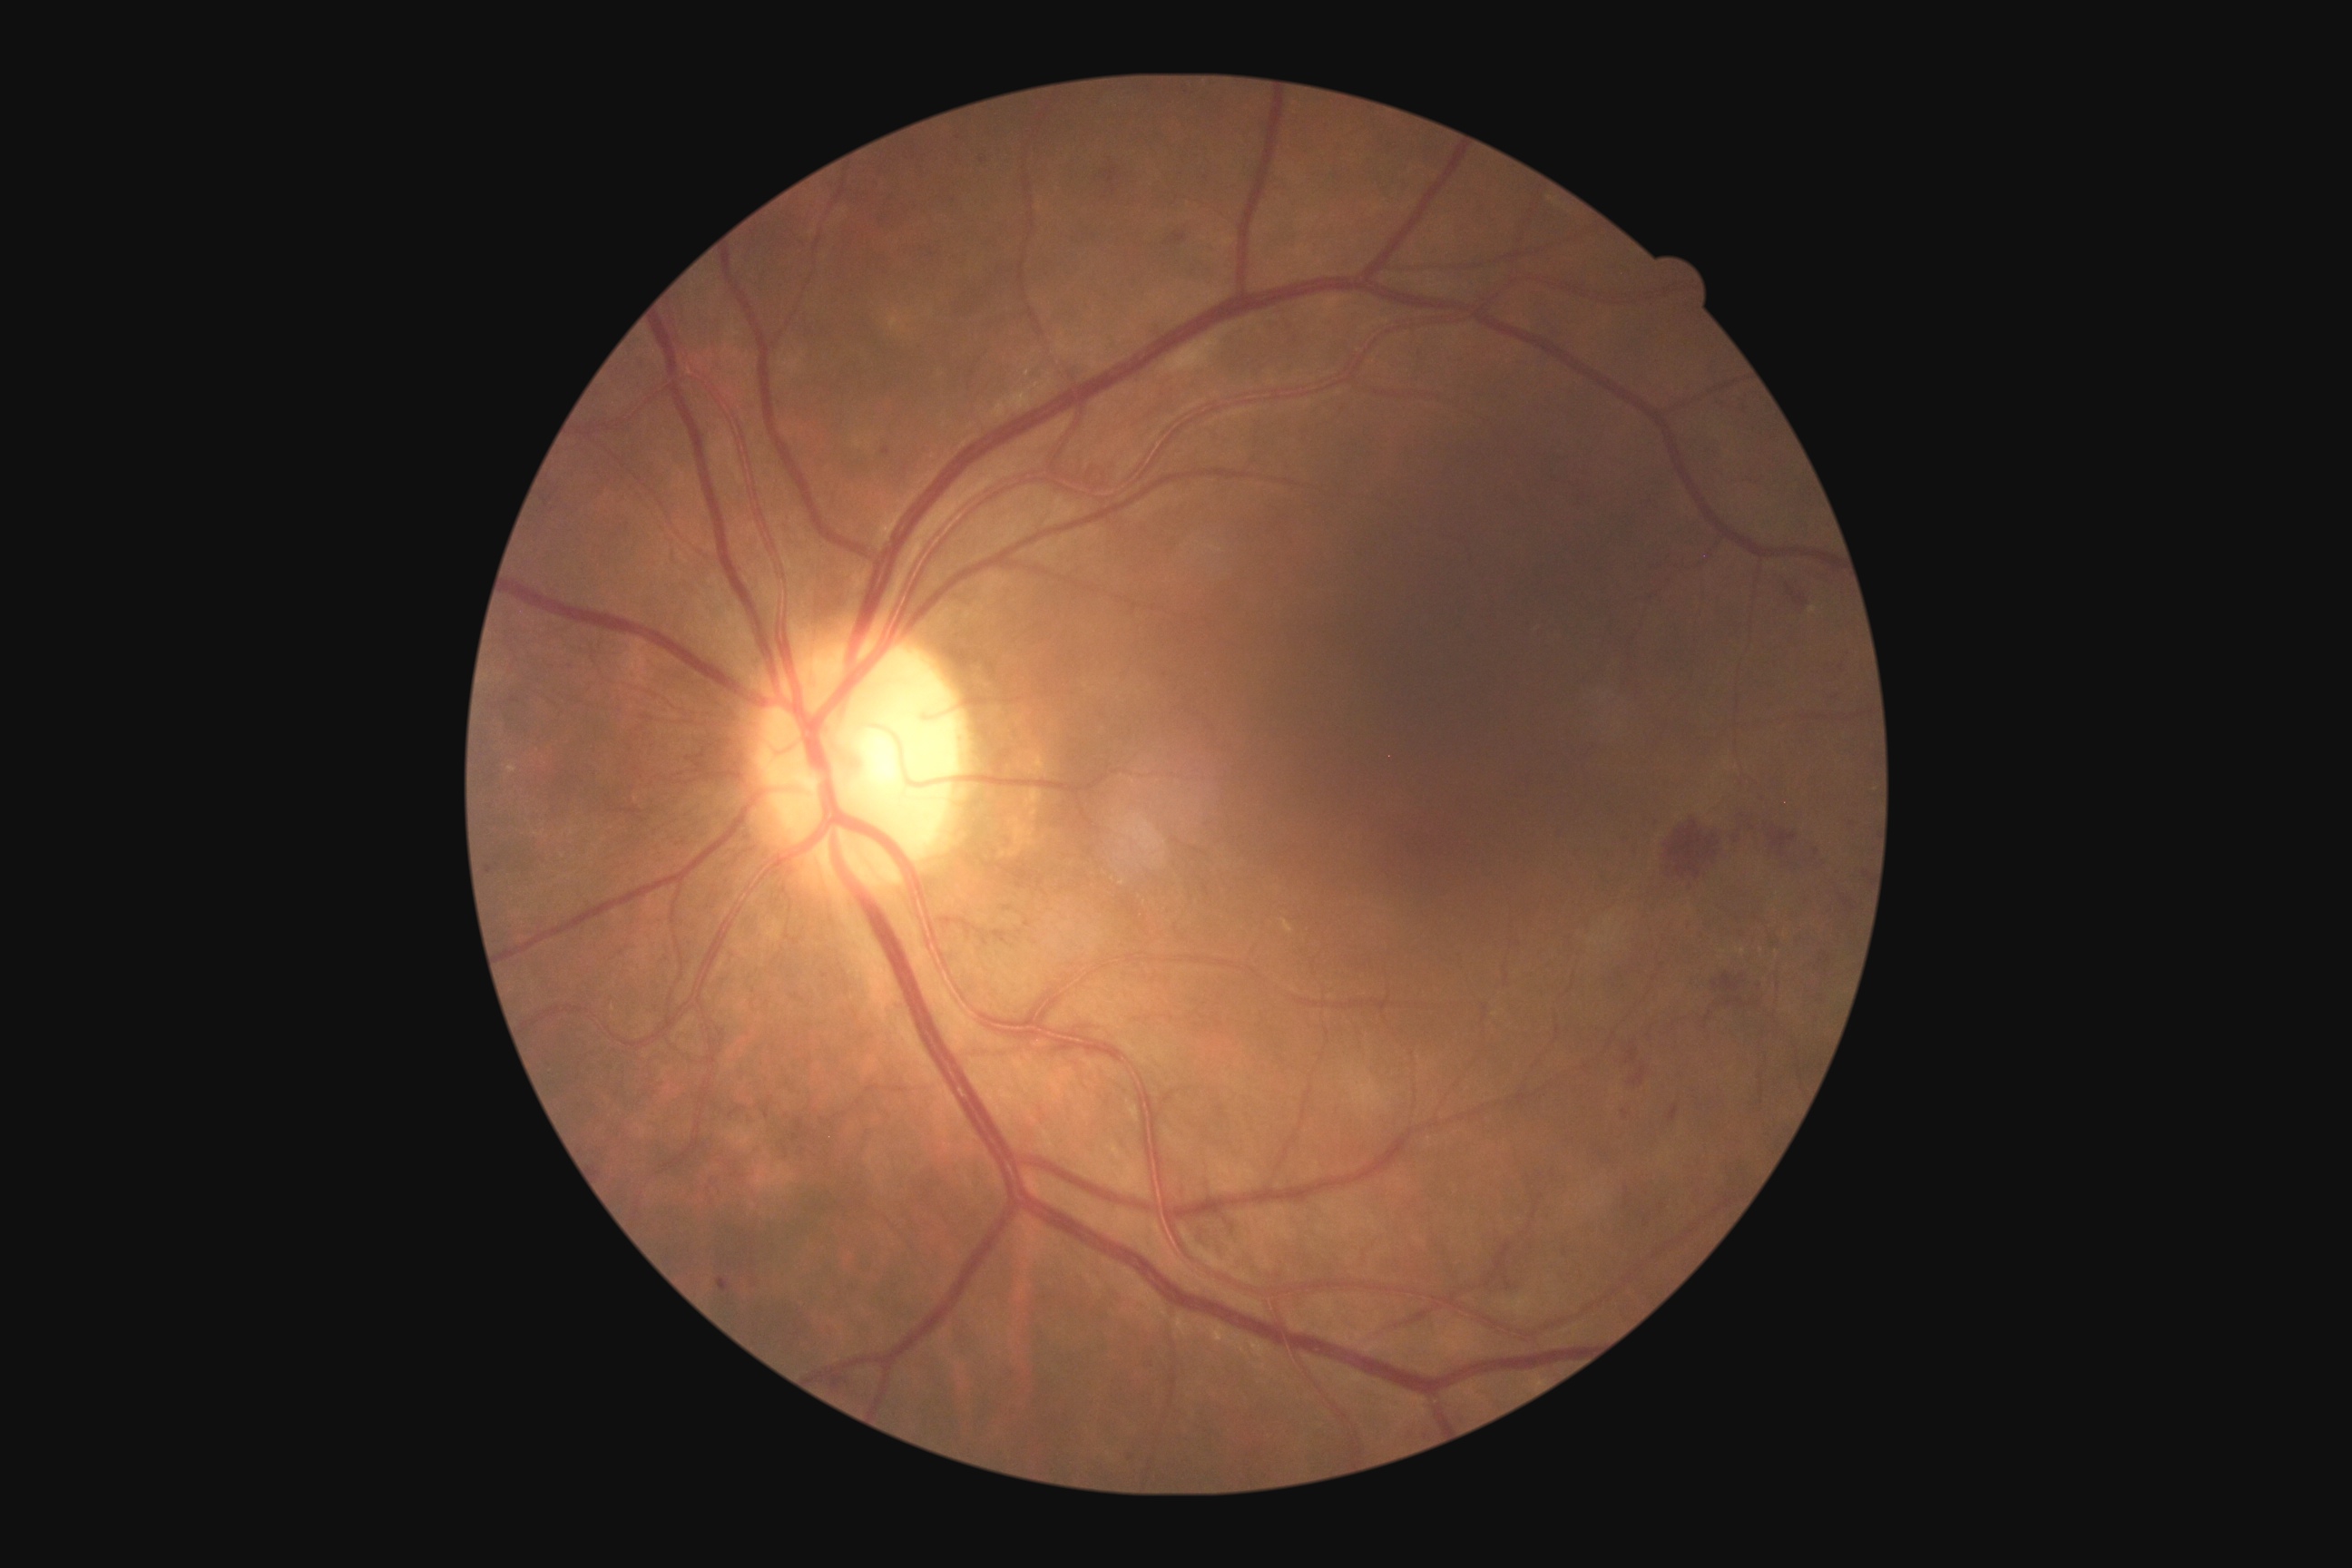 diabetic retinopathy severity: severe non-proliferative diabetic retinopathy (grade 3)
DR class: non-proliferative diabetic retinopathy